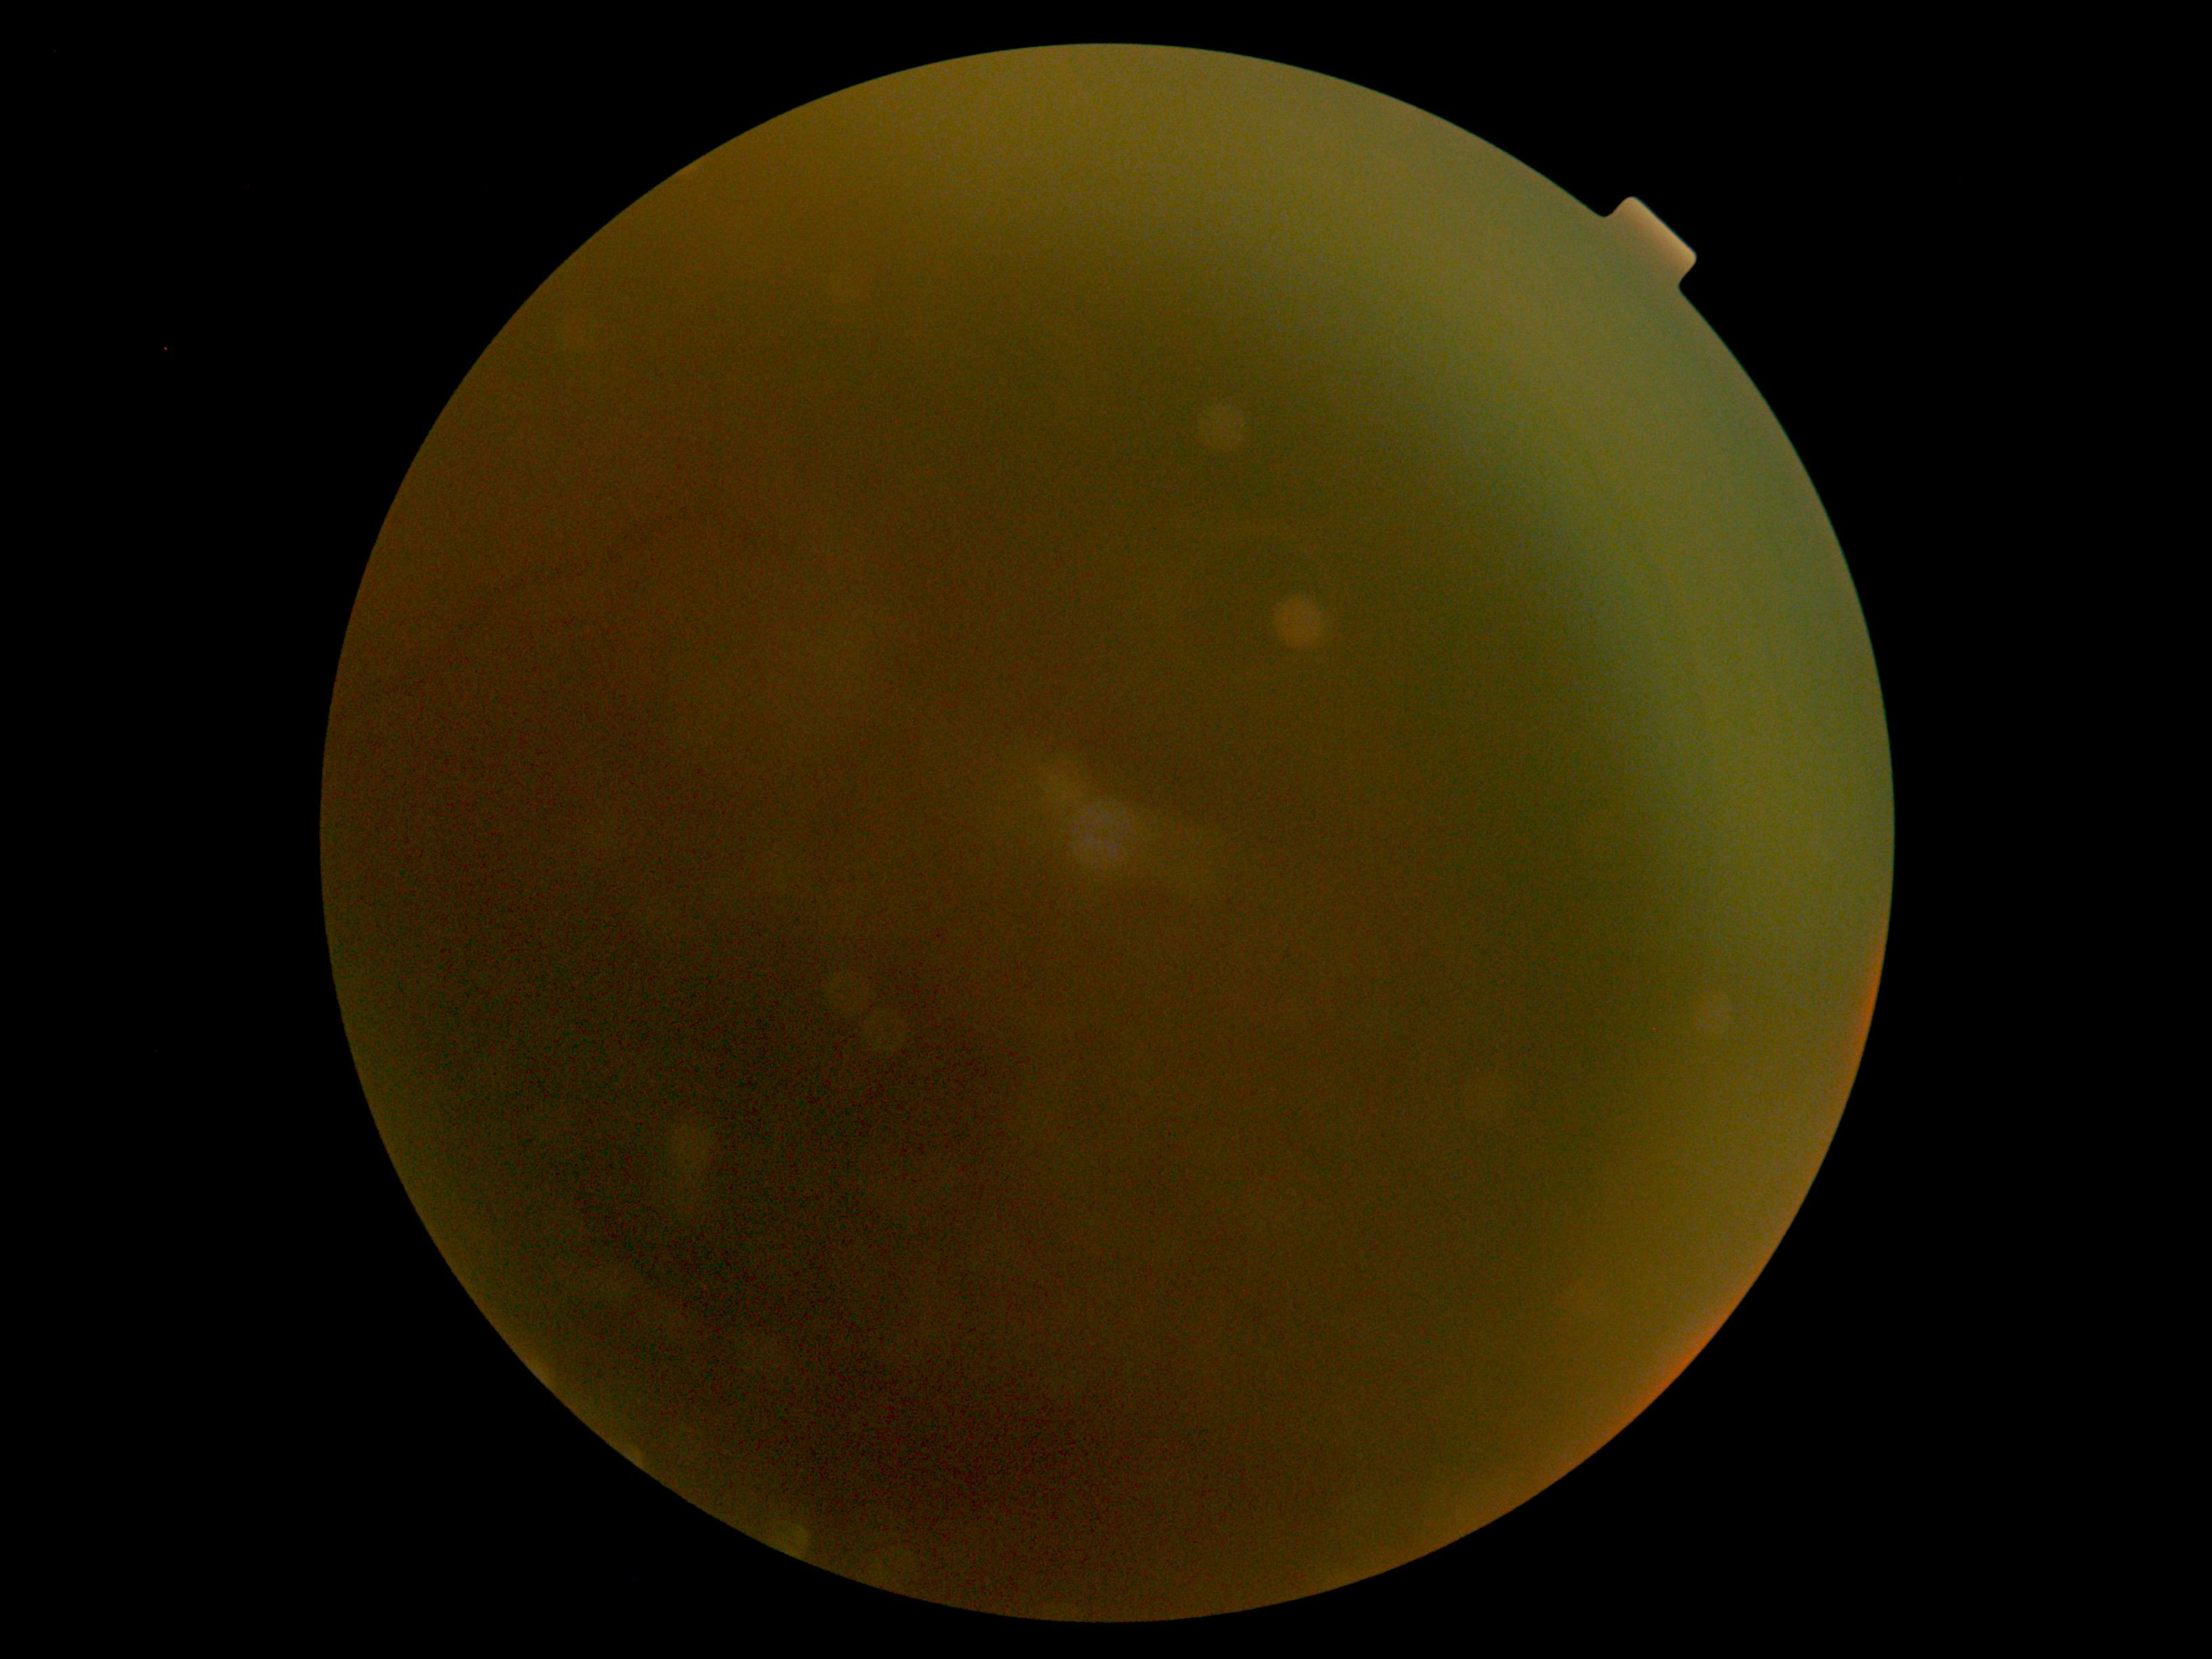

Retinopathy grade: ungradable.